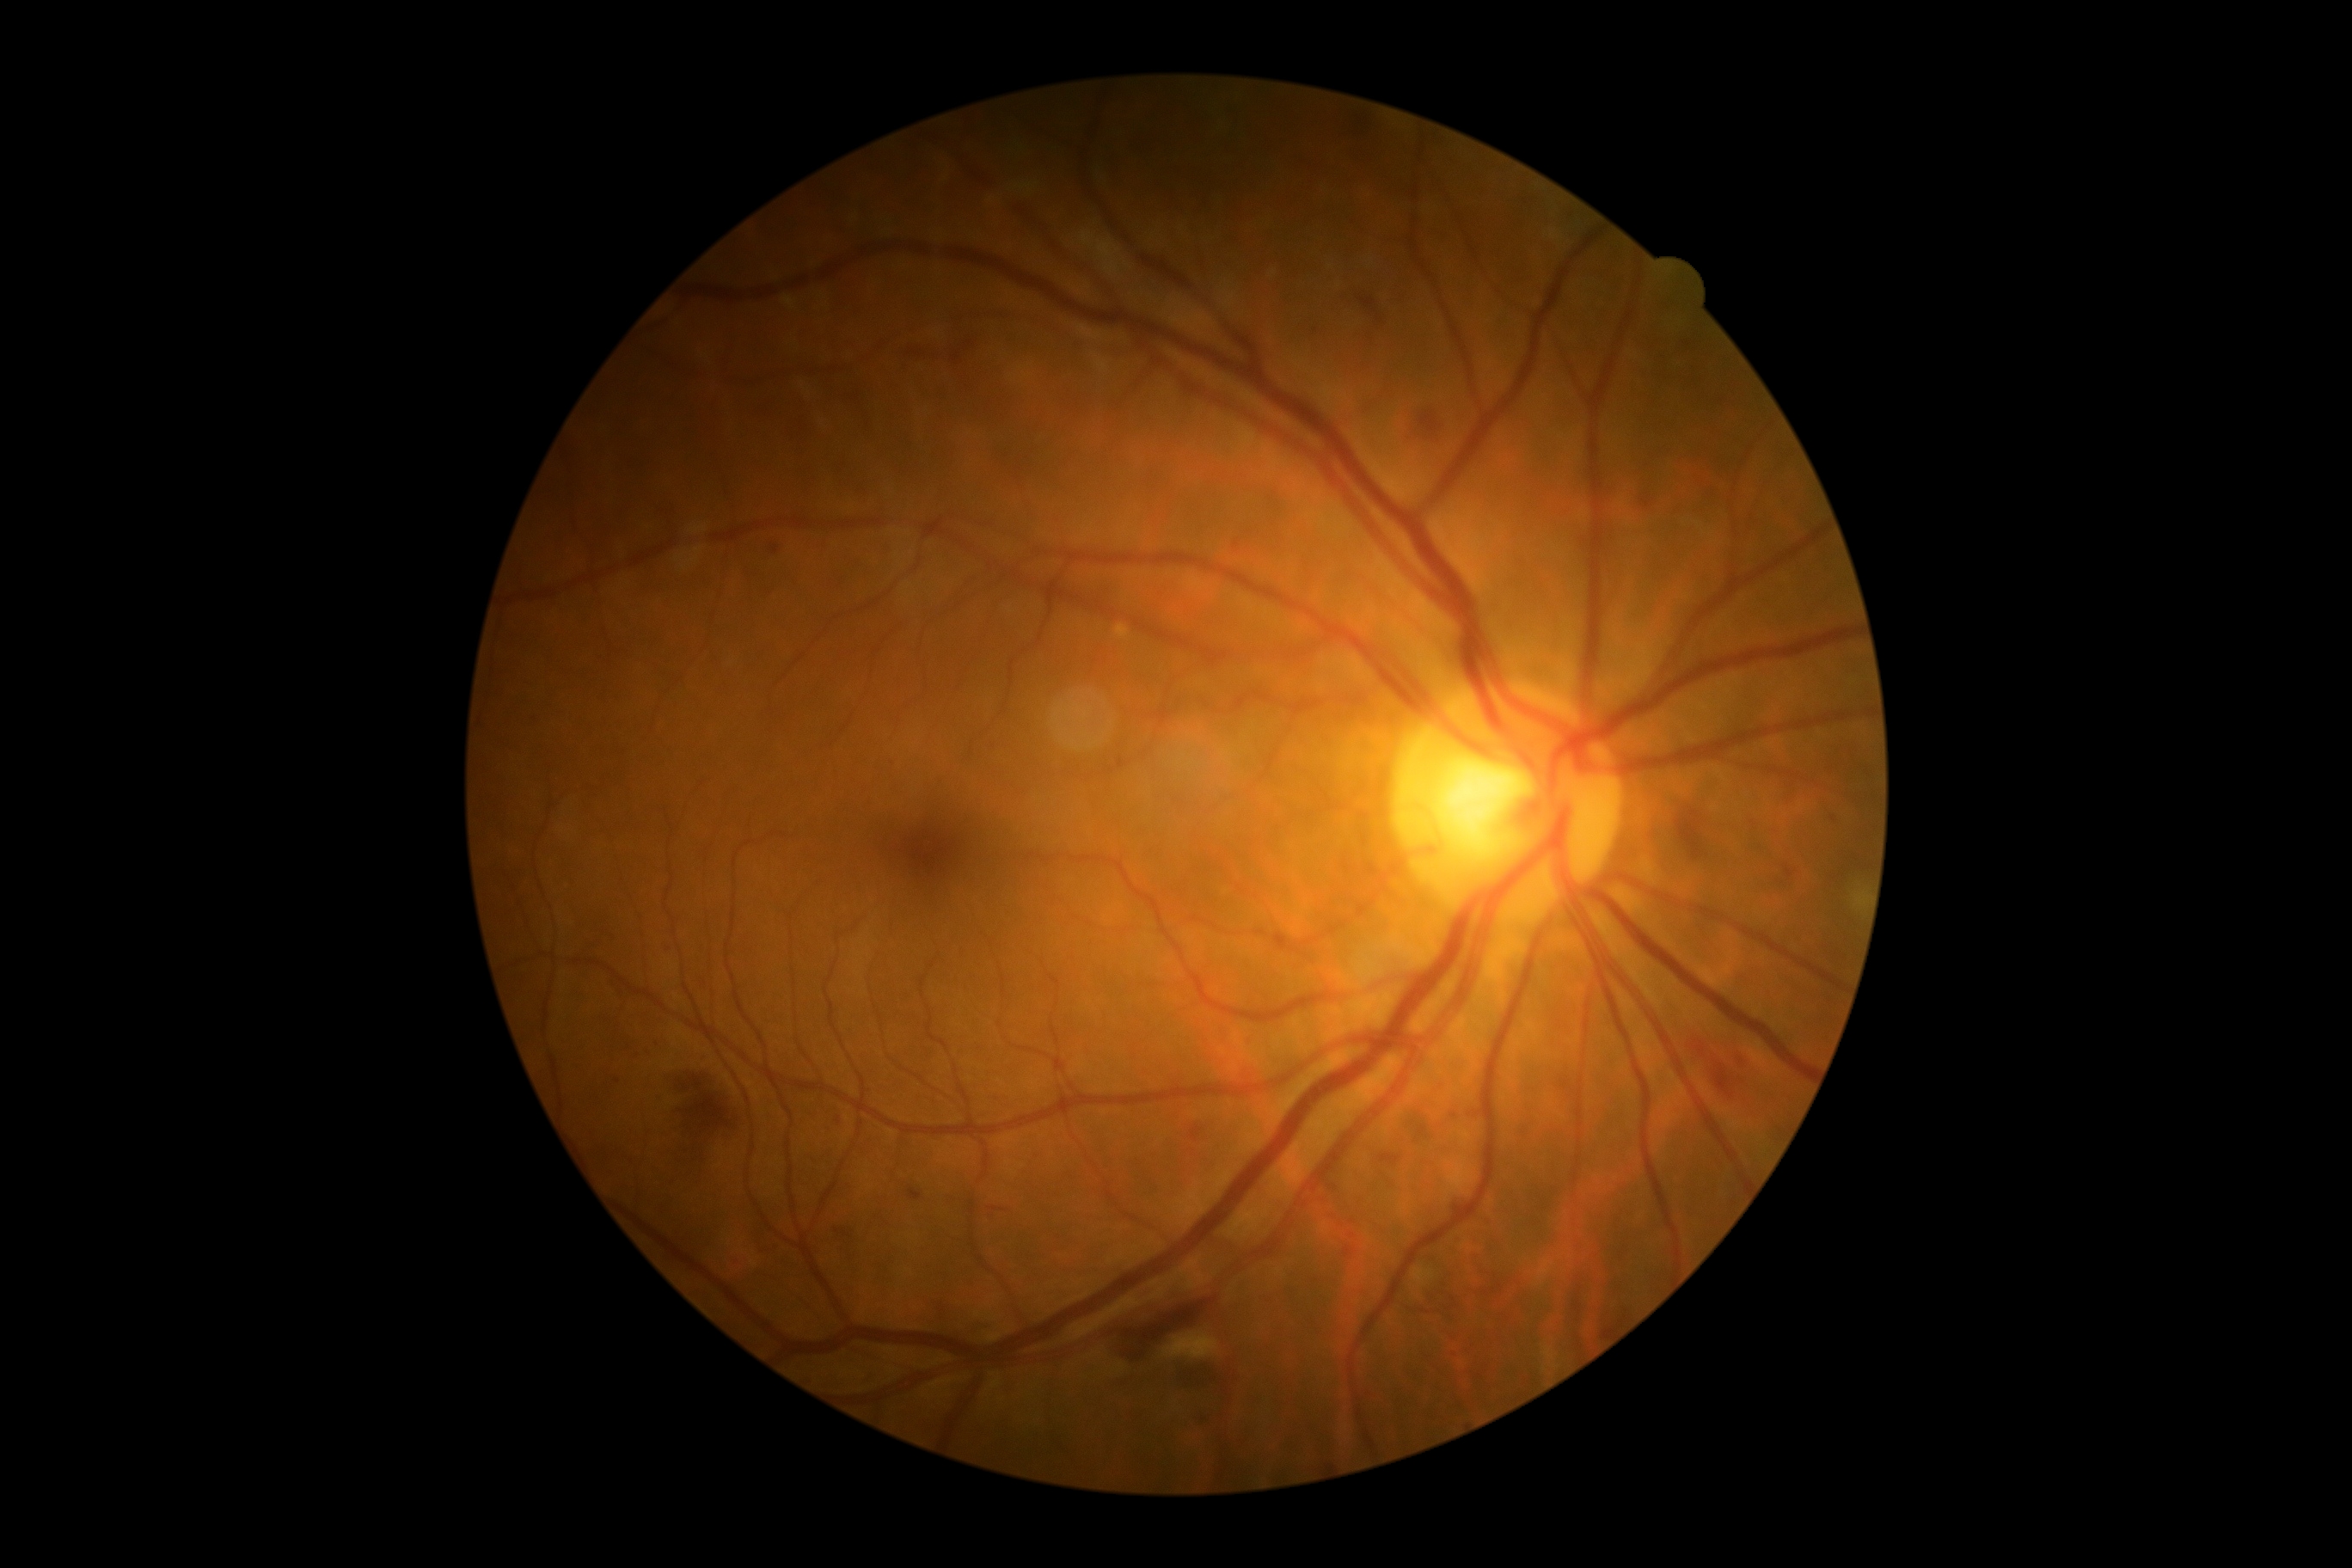   dr_grade: 2/4